Posterior pole color fundus photograph; nonmydriatic fundus photograph; NIDEK AFC-230; FOV: 45 degrees — 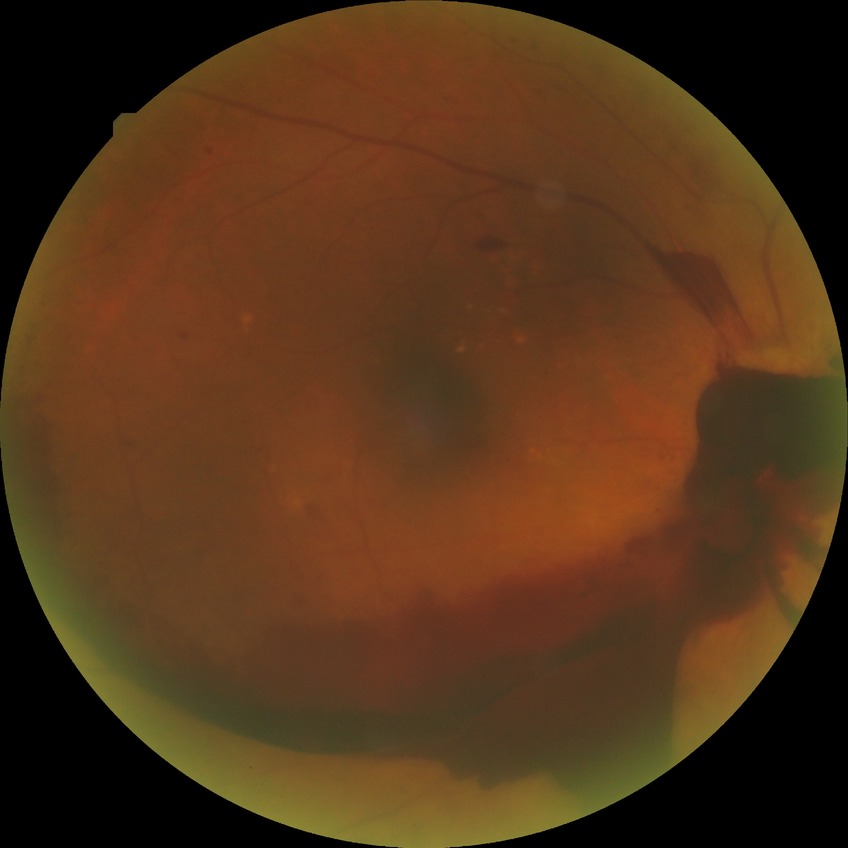

retinopathy stage = proliferative diabetic retinopathy.